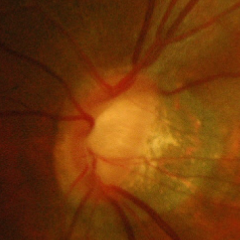

Demonstrates advanced glaucomatous optic neuropathy.